Disc-centered field; 240 by 240 pixels:
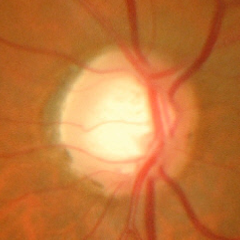
Impression = advanced glaucoma.